Wide-field fundus photograph of an infant · image size 1240x1240:
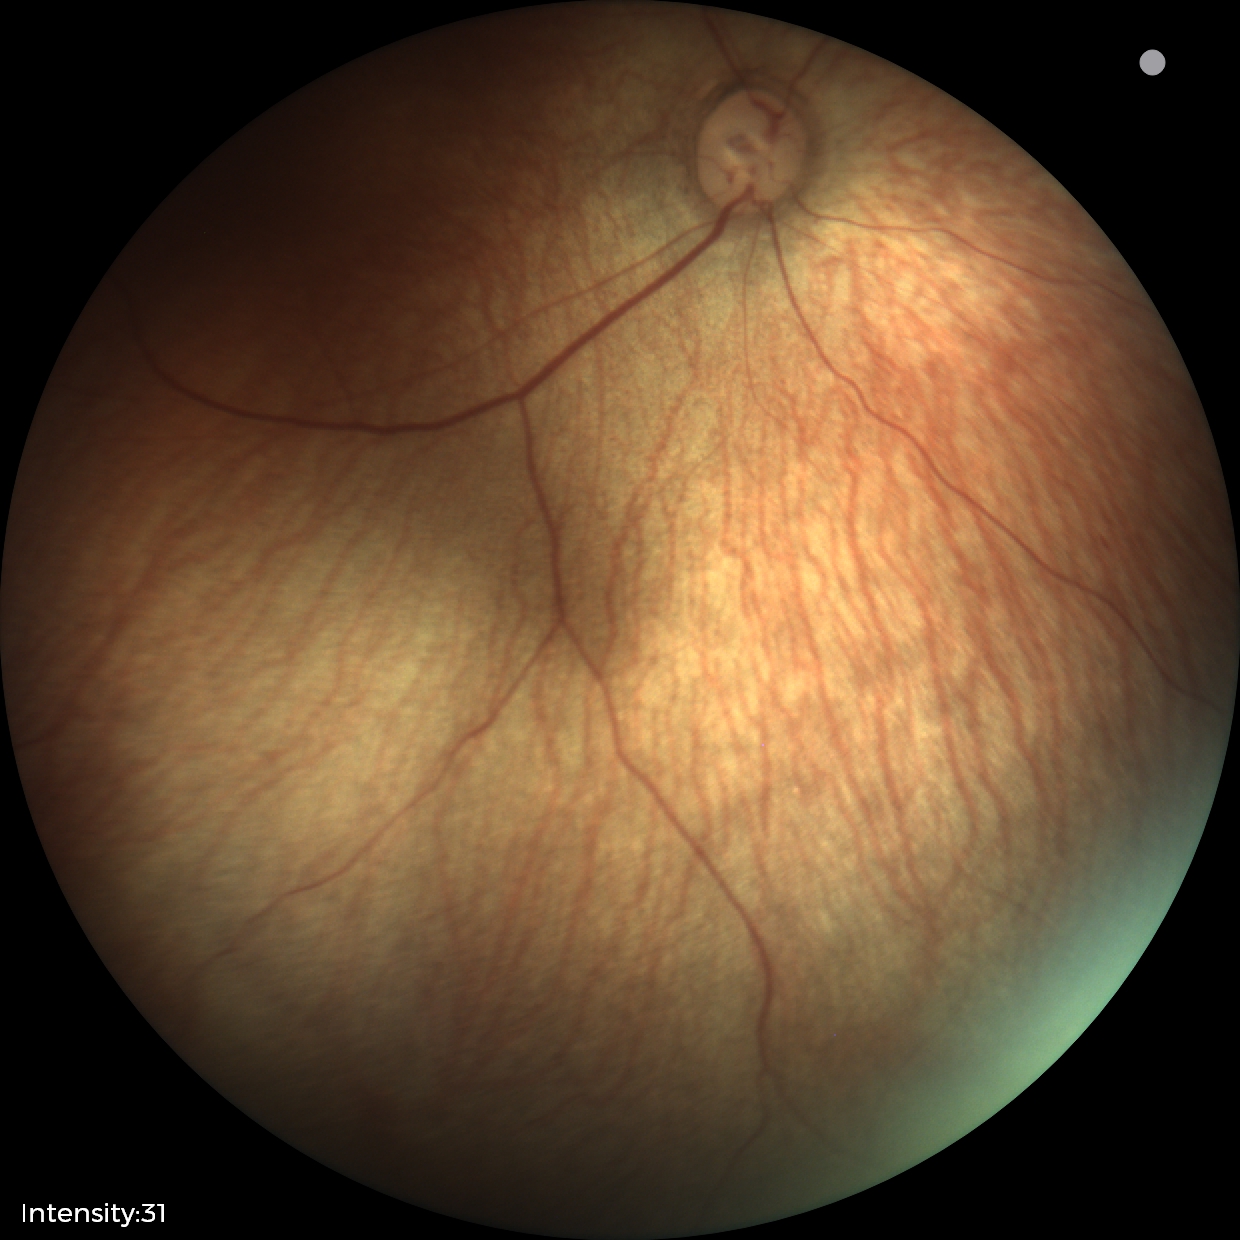
Examination with physiological retinal findings.